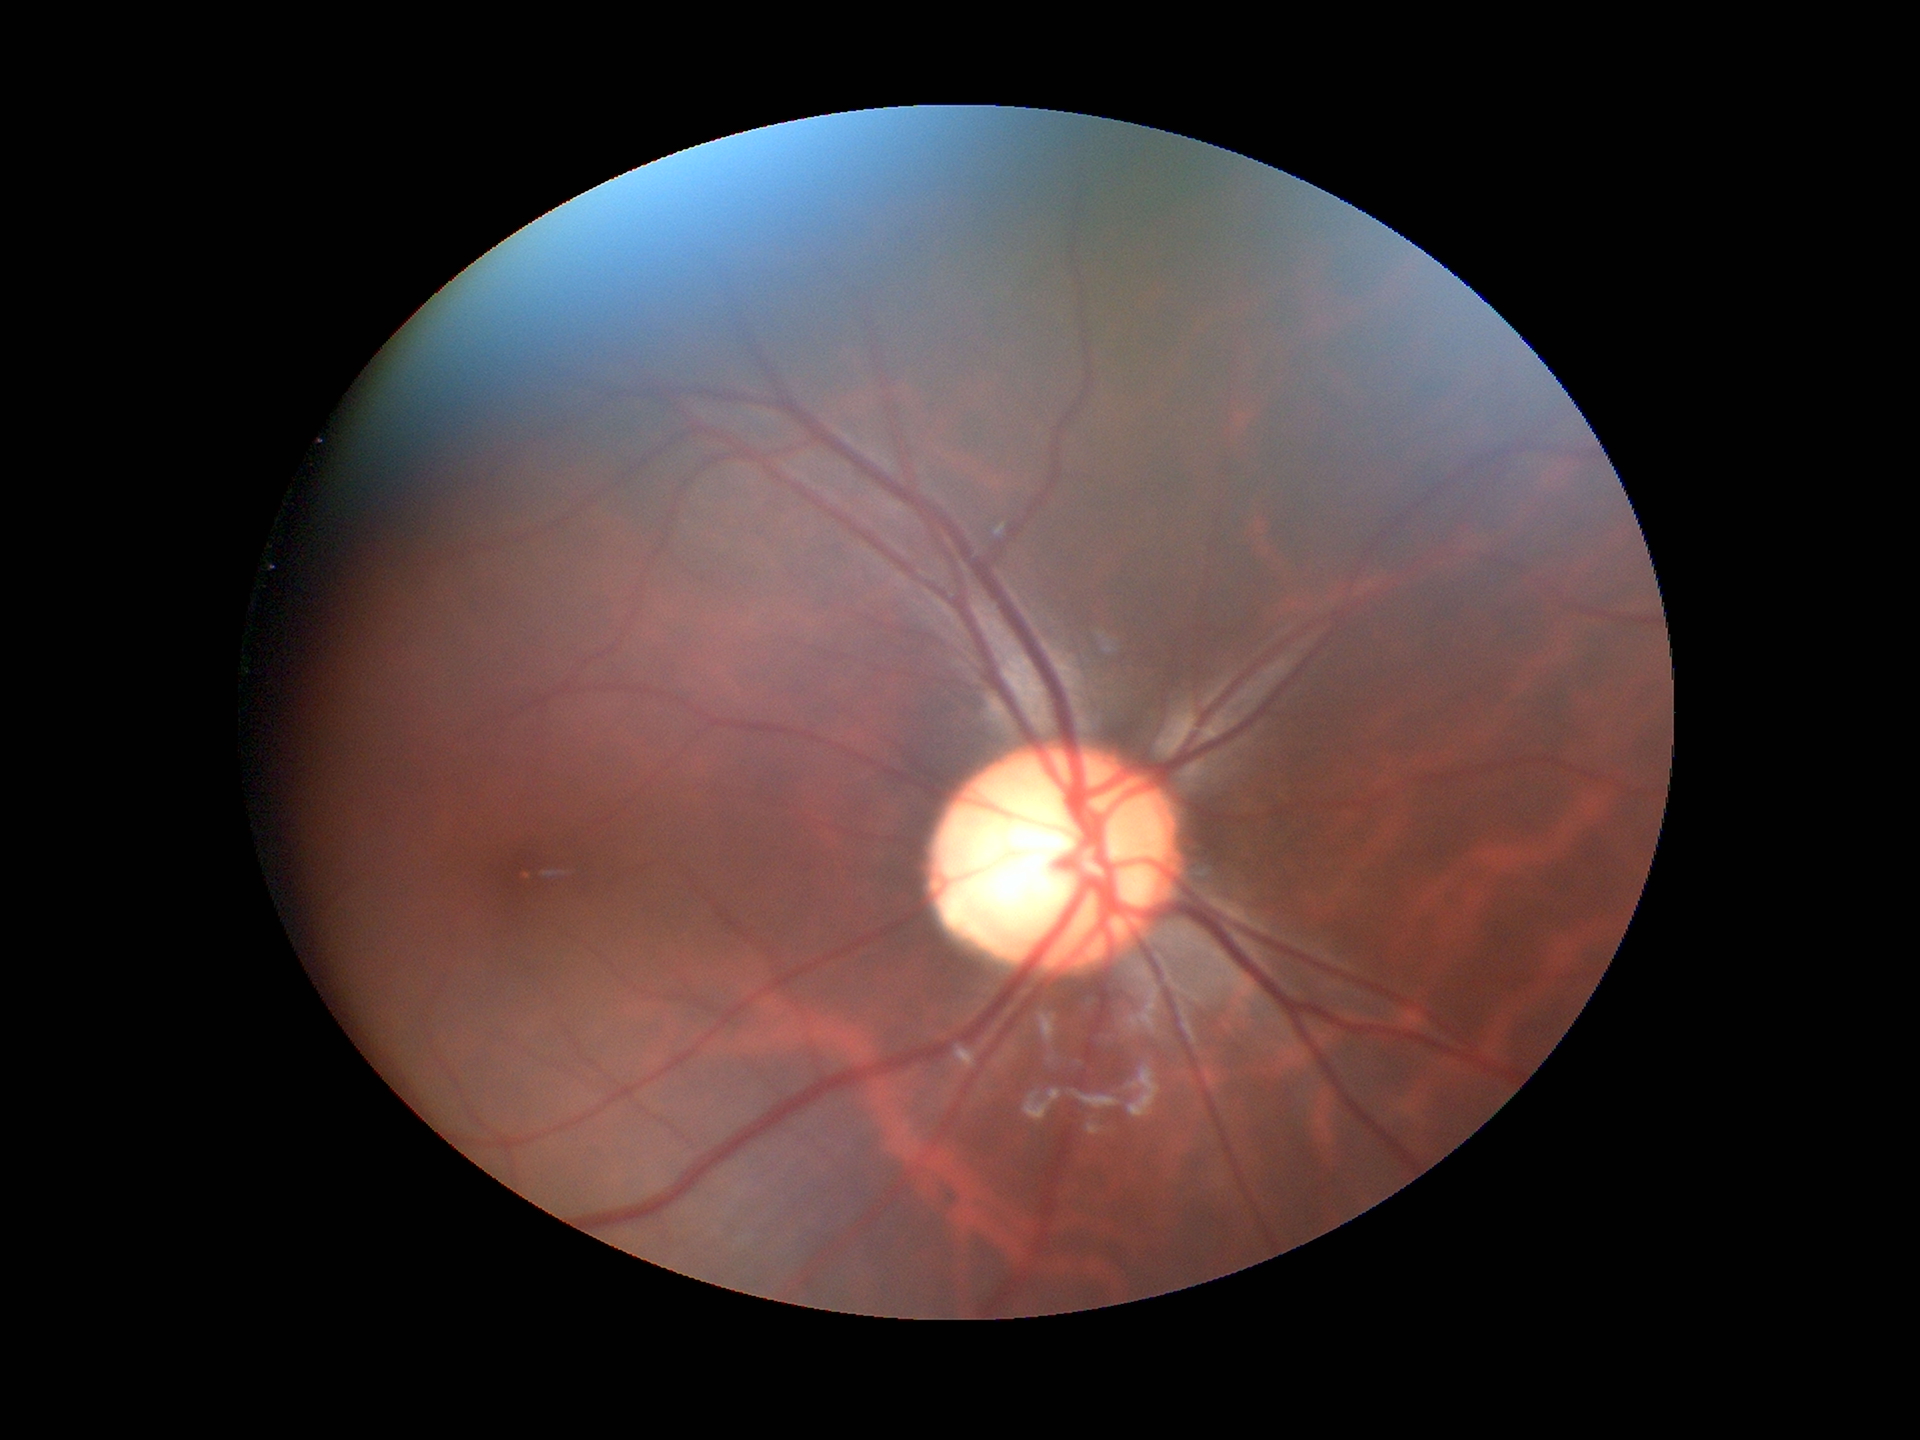 - Glaucoma impression: suspicious
- vertical cup-disc ratio: 0.63